Handheld portable fundus camera image — 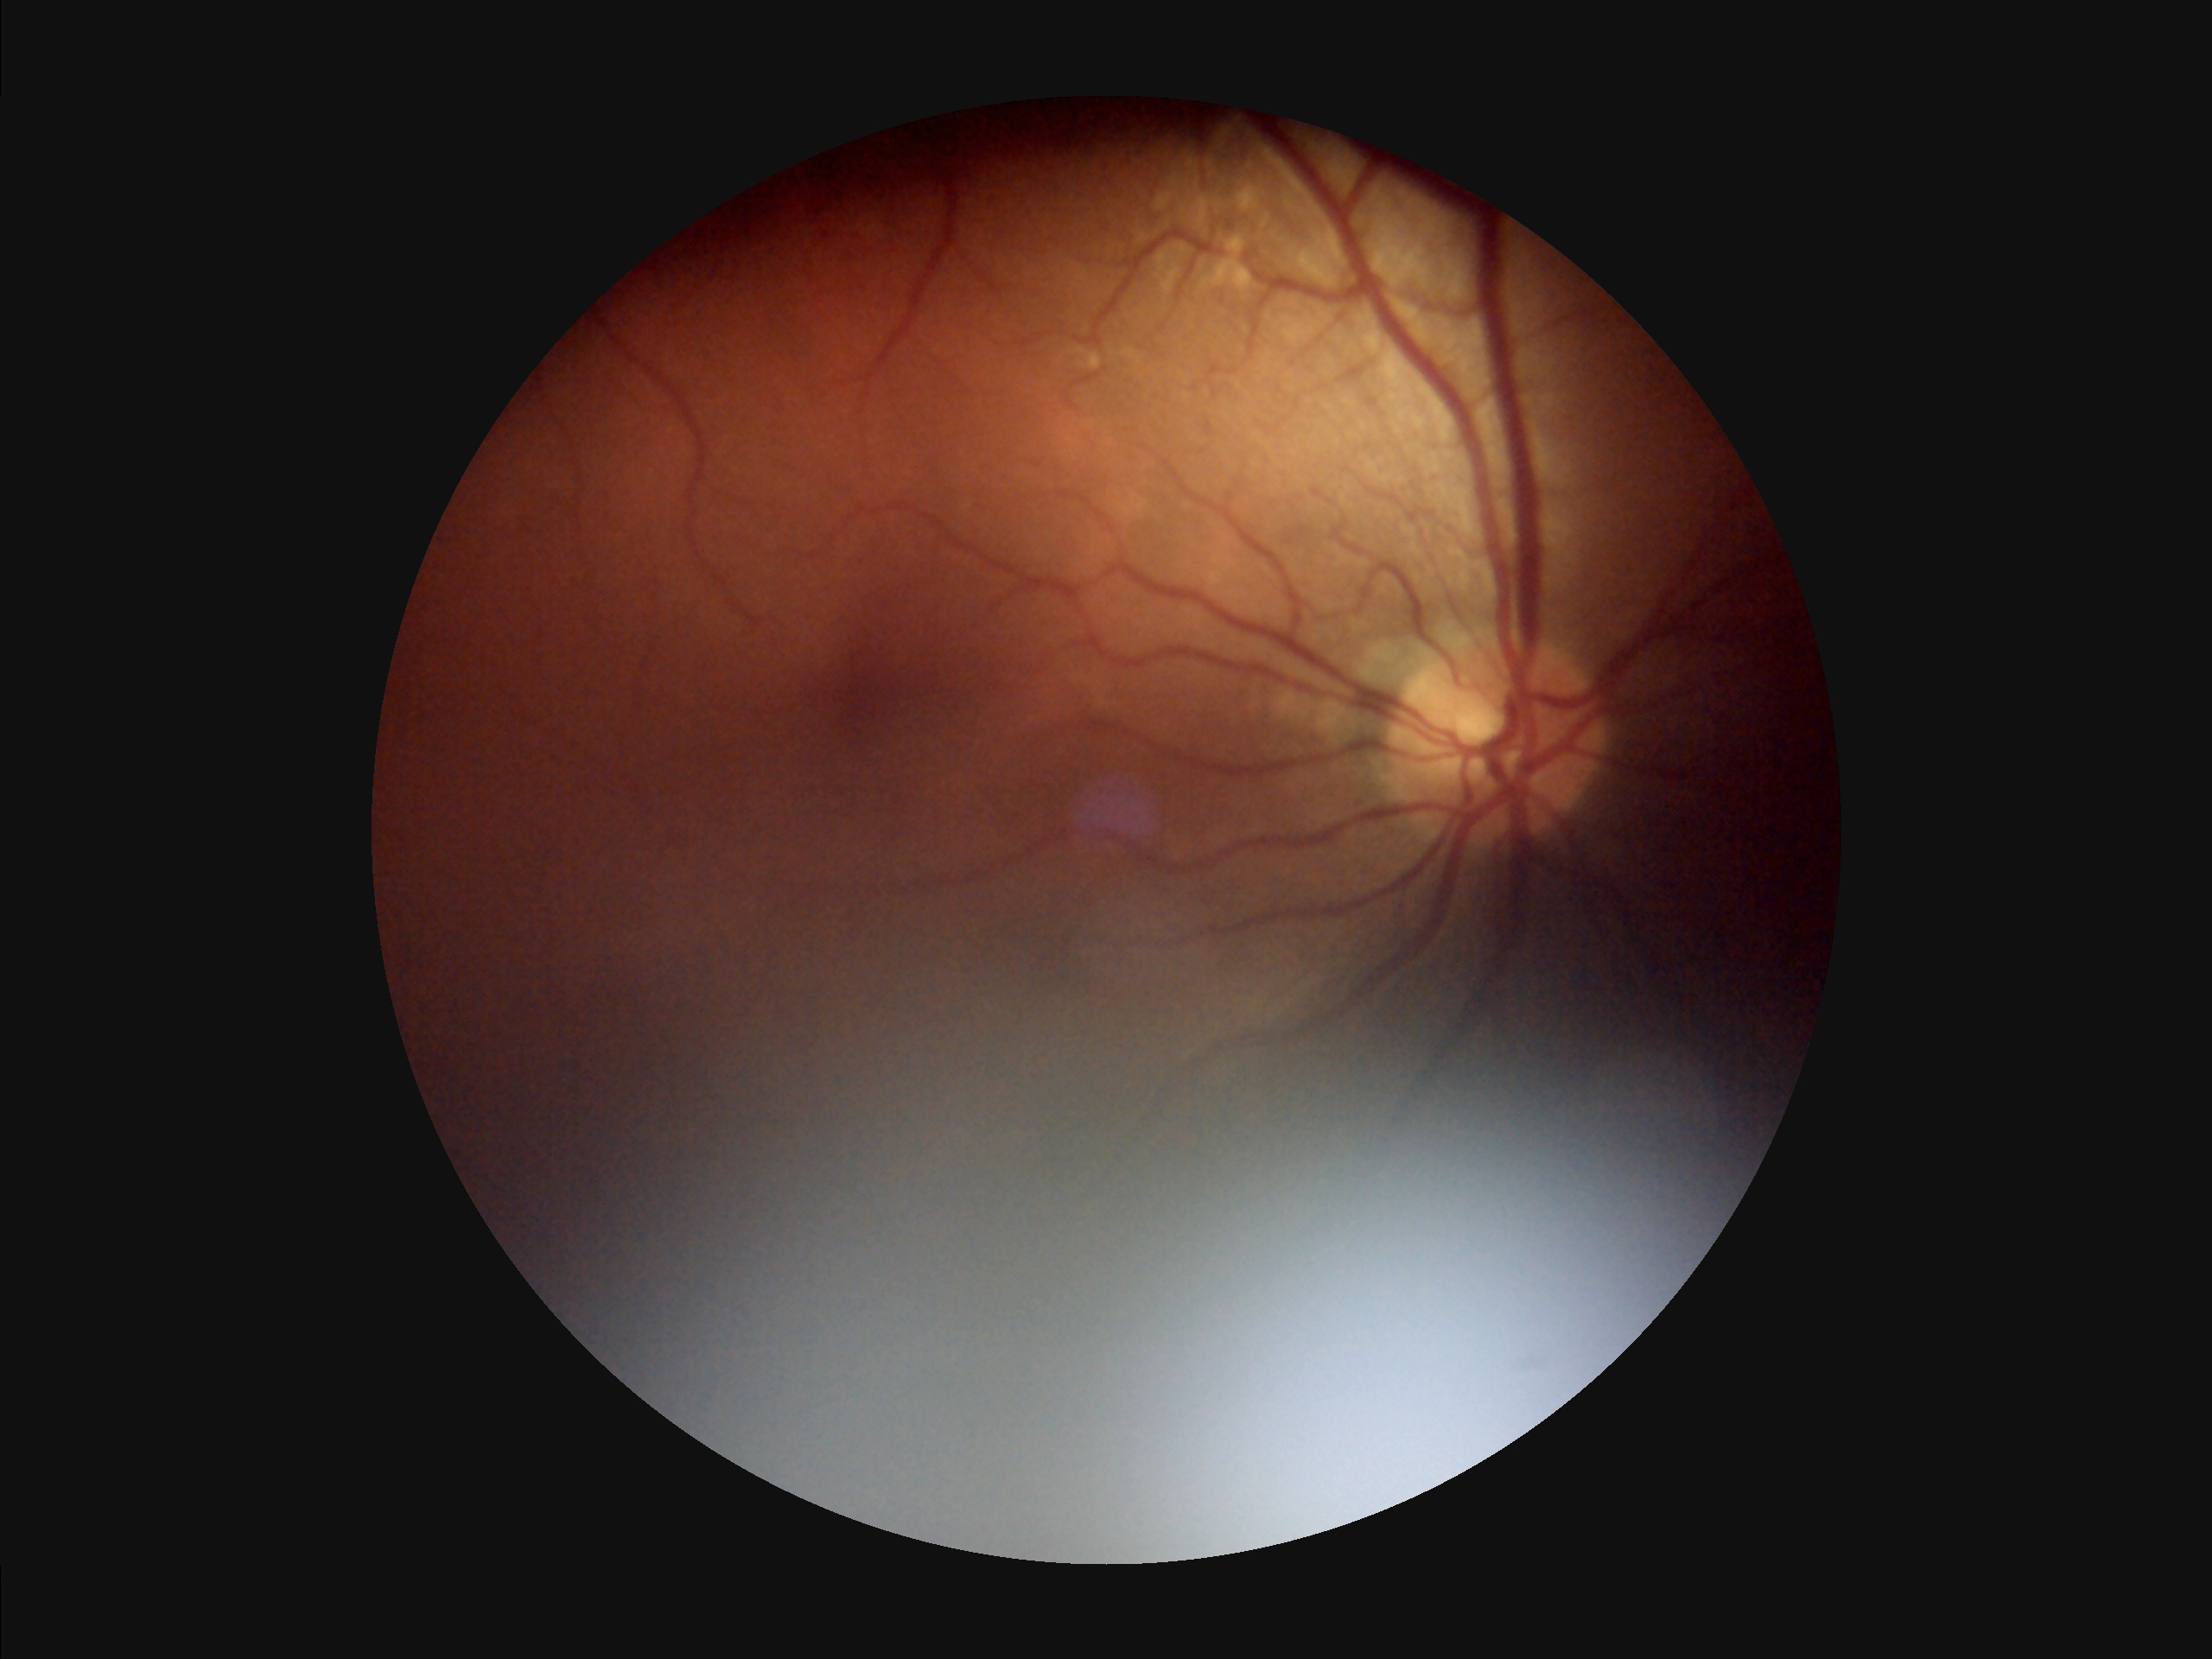
Overall quality: poor and difficult to use diagnostically | Illumination/color: uneven illumination or color cast | Clarity: out of focus, structures indistinct | Contrast: poor dynamic range.